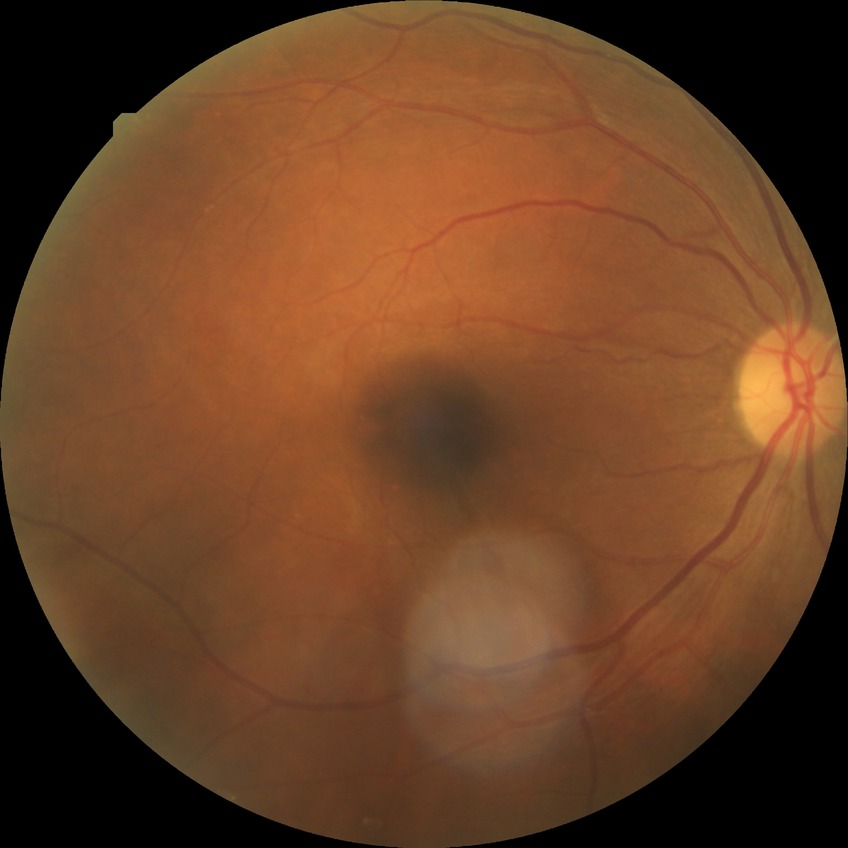 diabetic retinopathy (DR)@SDR (simple diabetic retinopathy).